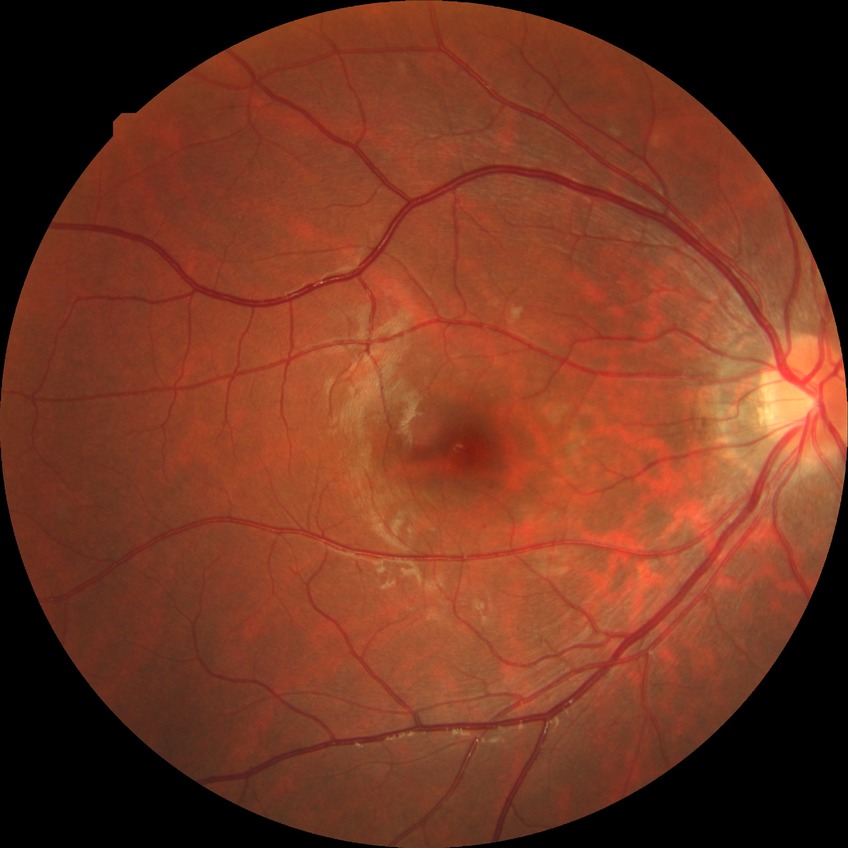

diabetic retinopathy stage = no diabetic retinopathy.